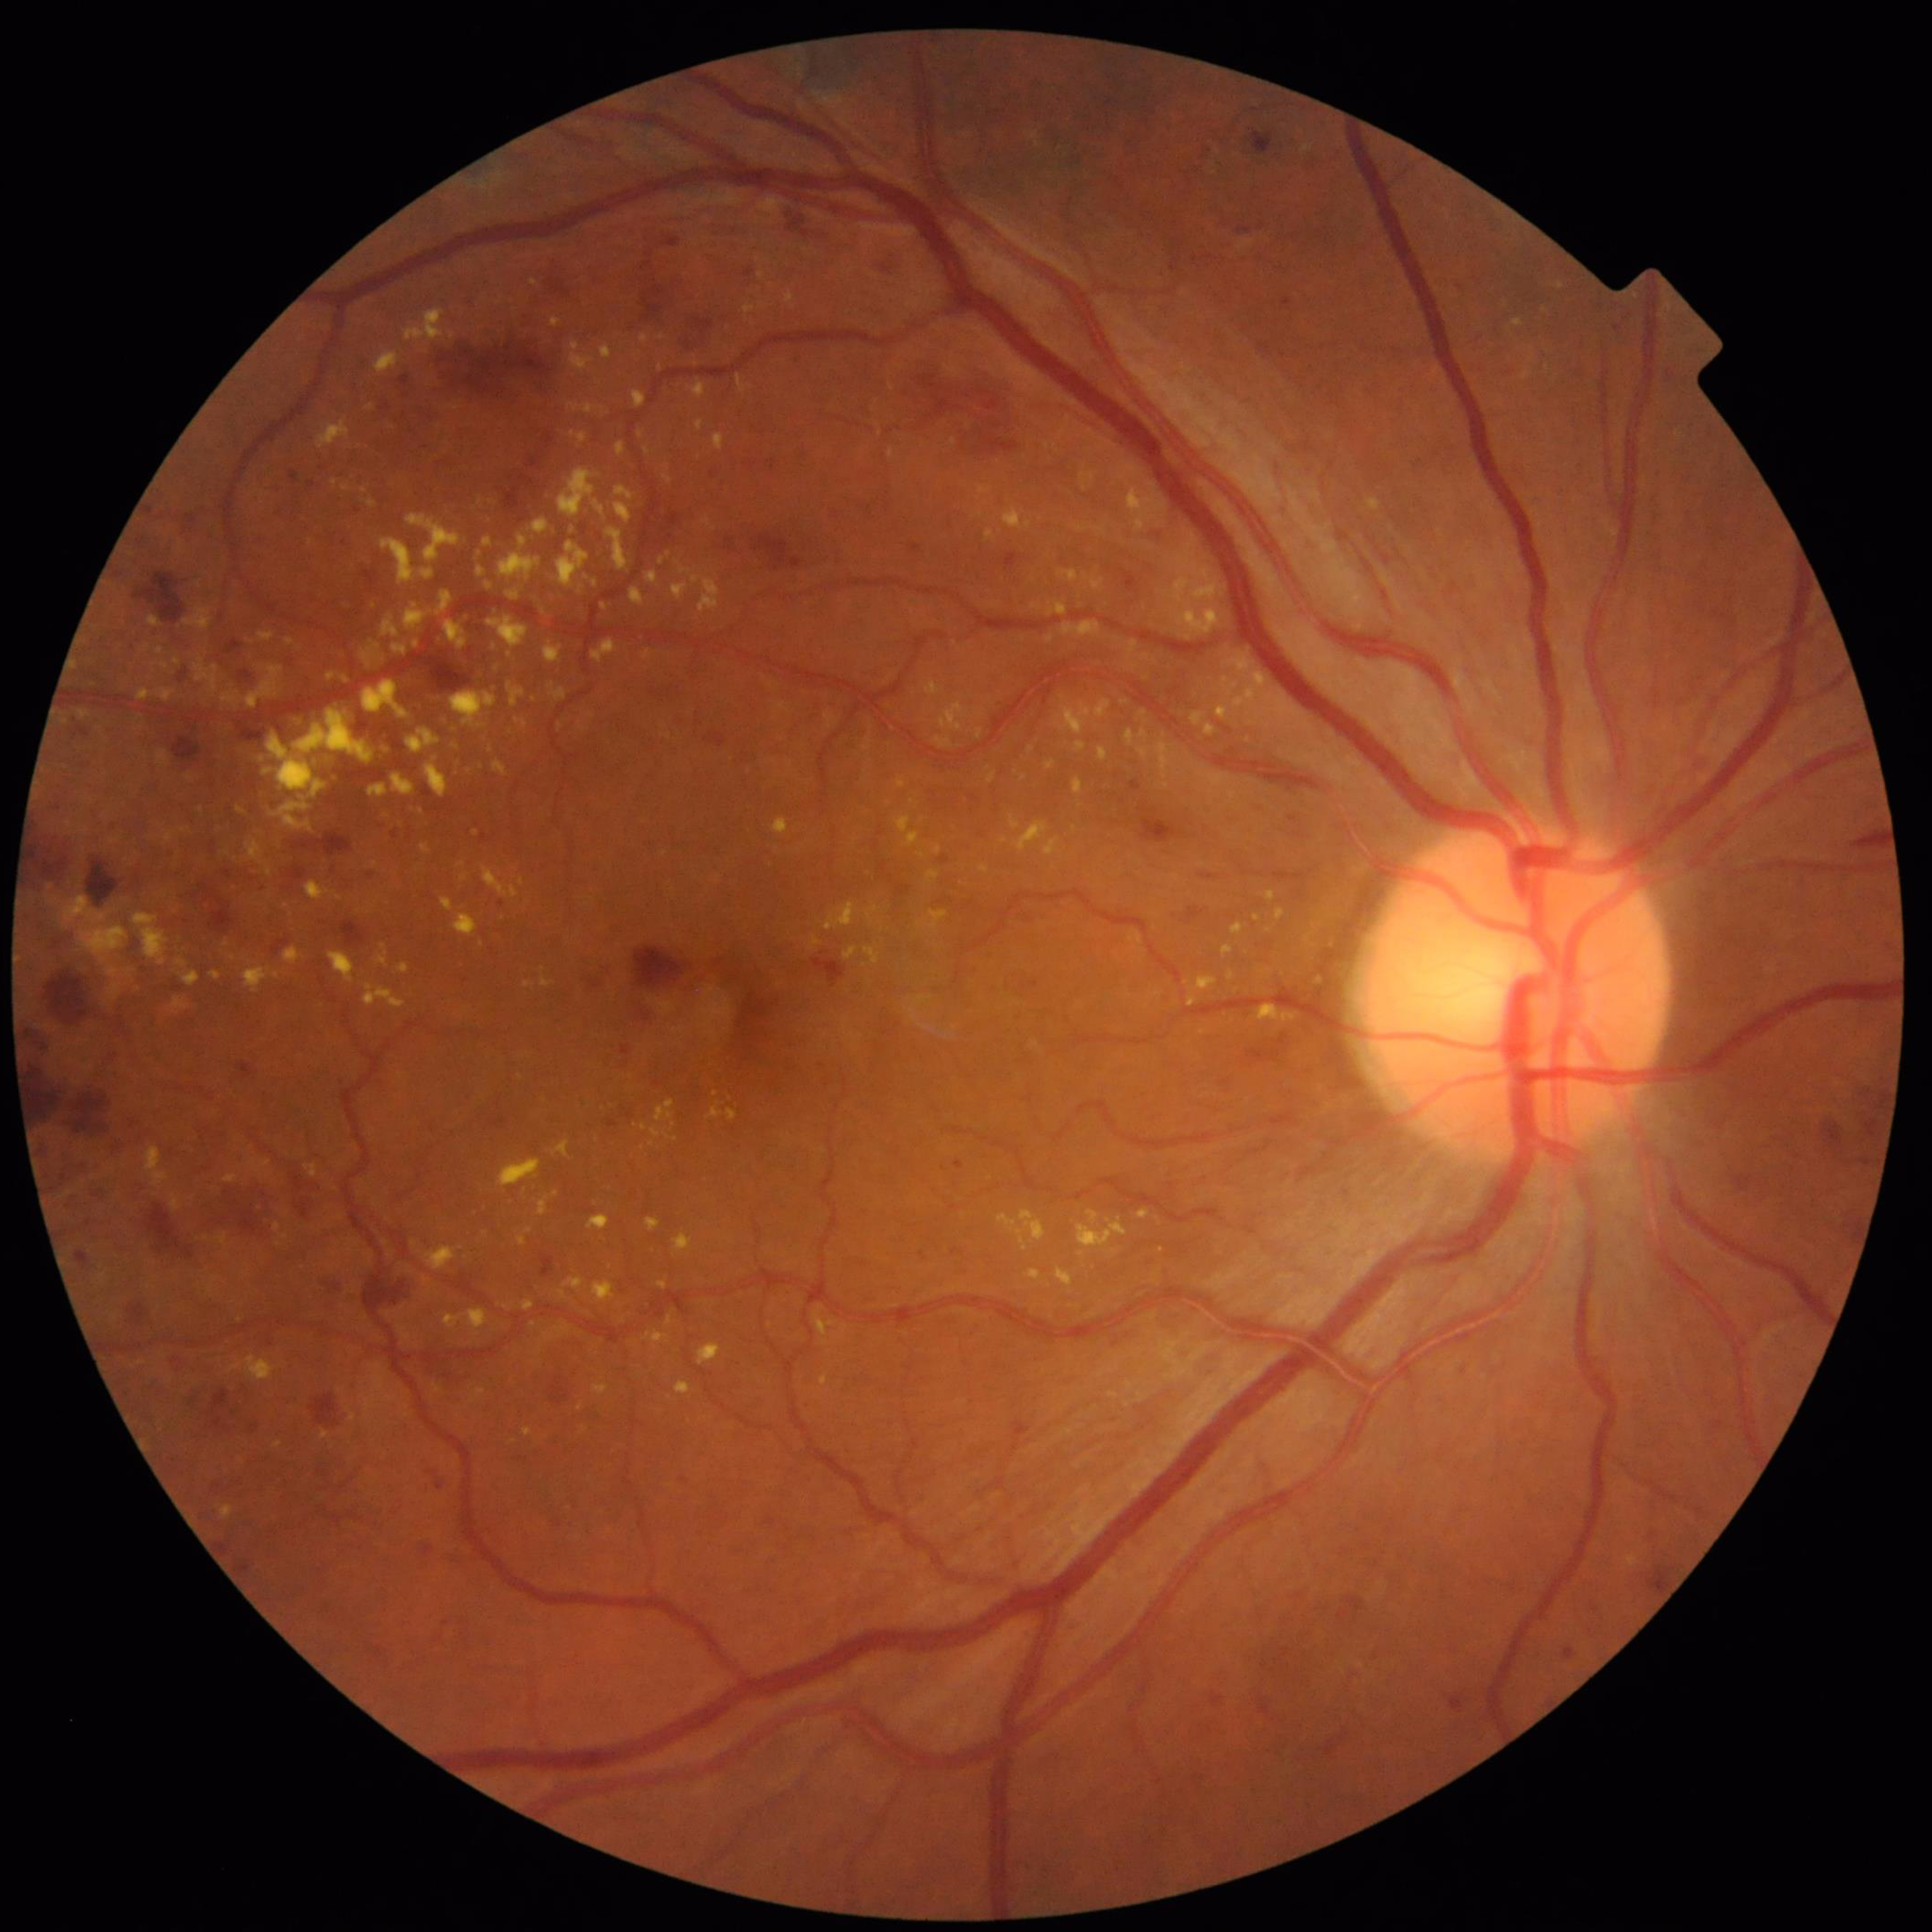

Color fundus photo. Patient diagnosed with diabetic retinopathy.